Wide-field fundus image from infant ROP screening — 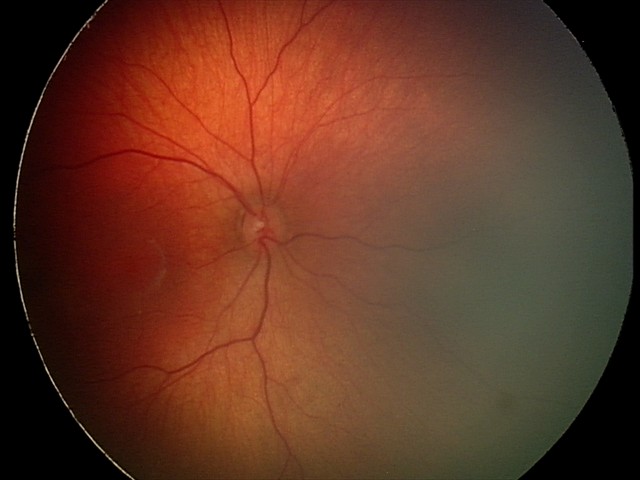
Screening series with retinal hemorrhages.